Color fundus photograph · 2352 by 1568 pixels
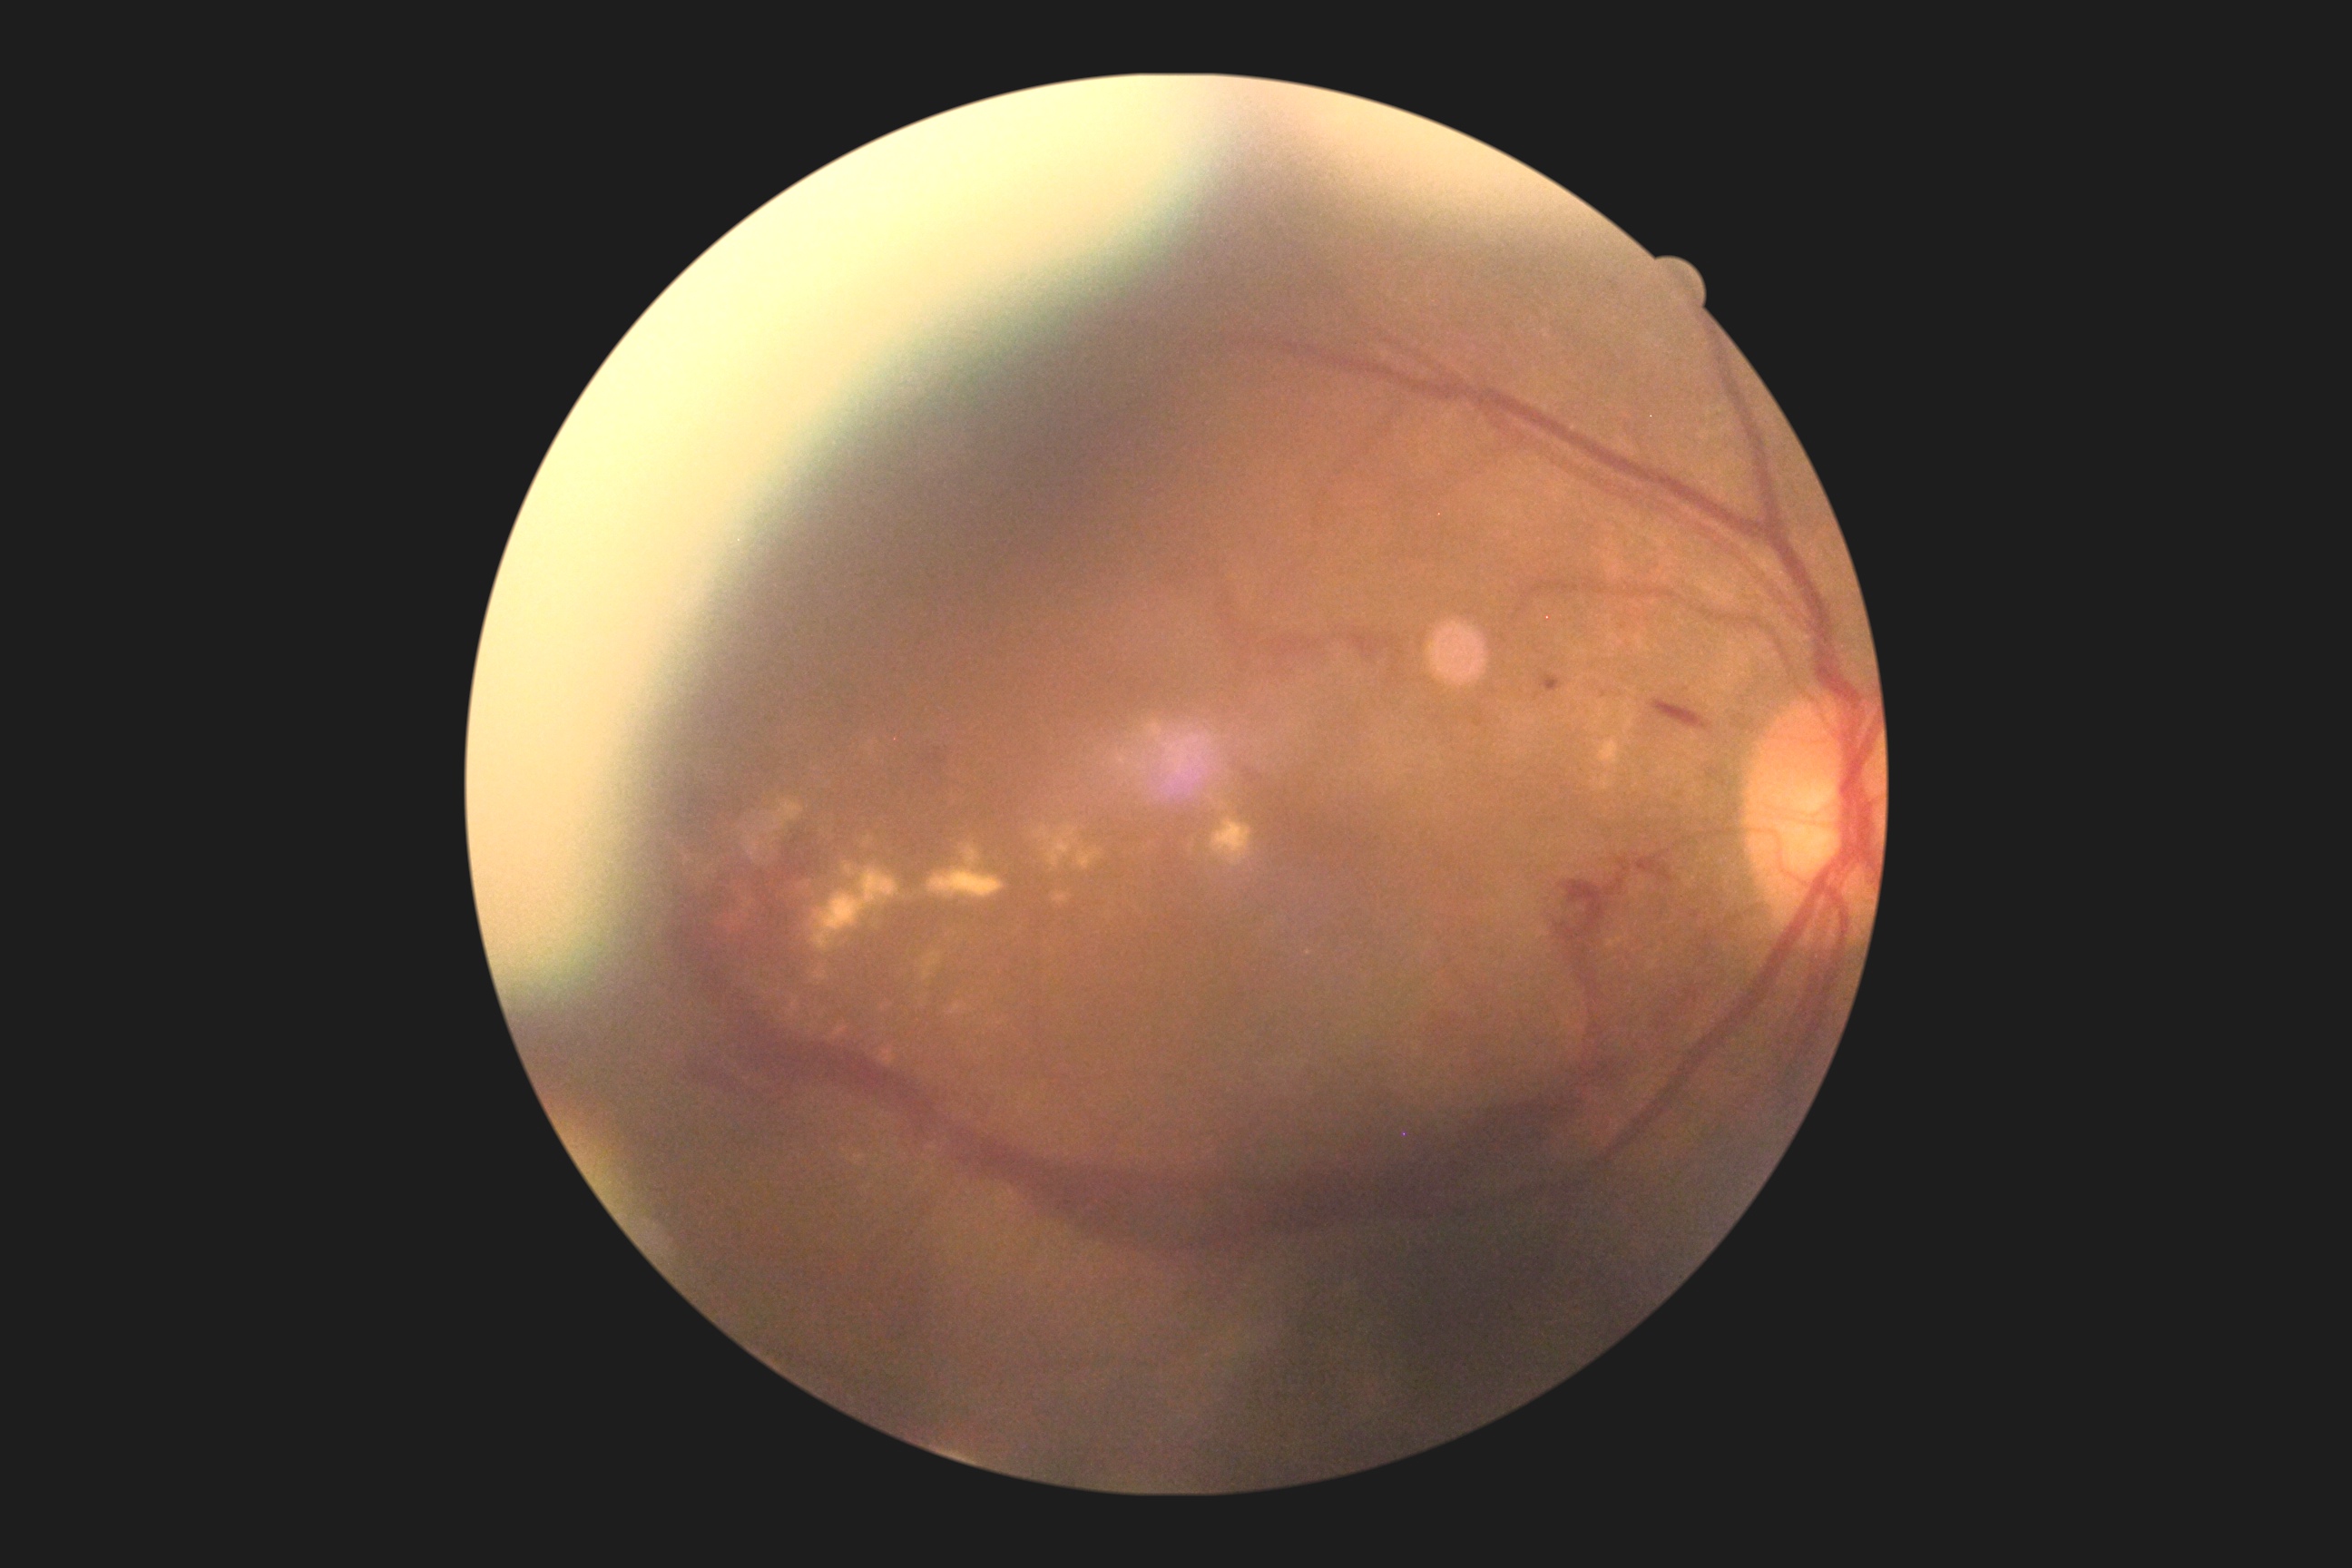
The retinopathy is classified as proliferative diabetic retinopathy. Diabetic retinopathy severity: PDR (grade 4).